Intraocular pressure (IOP) 30 mmHg by pneumatic tonometry; axial length 22.58 mm; woman patient:
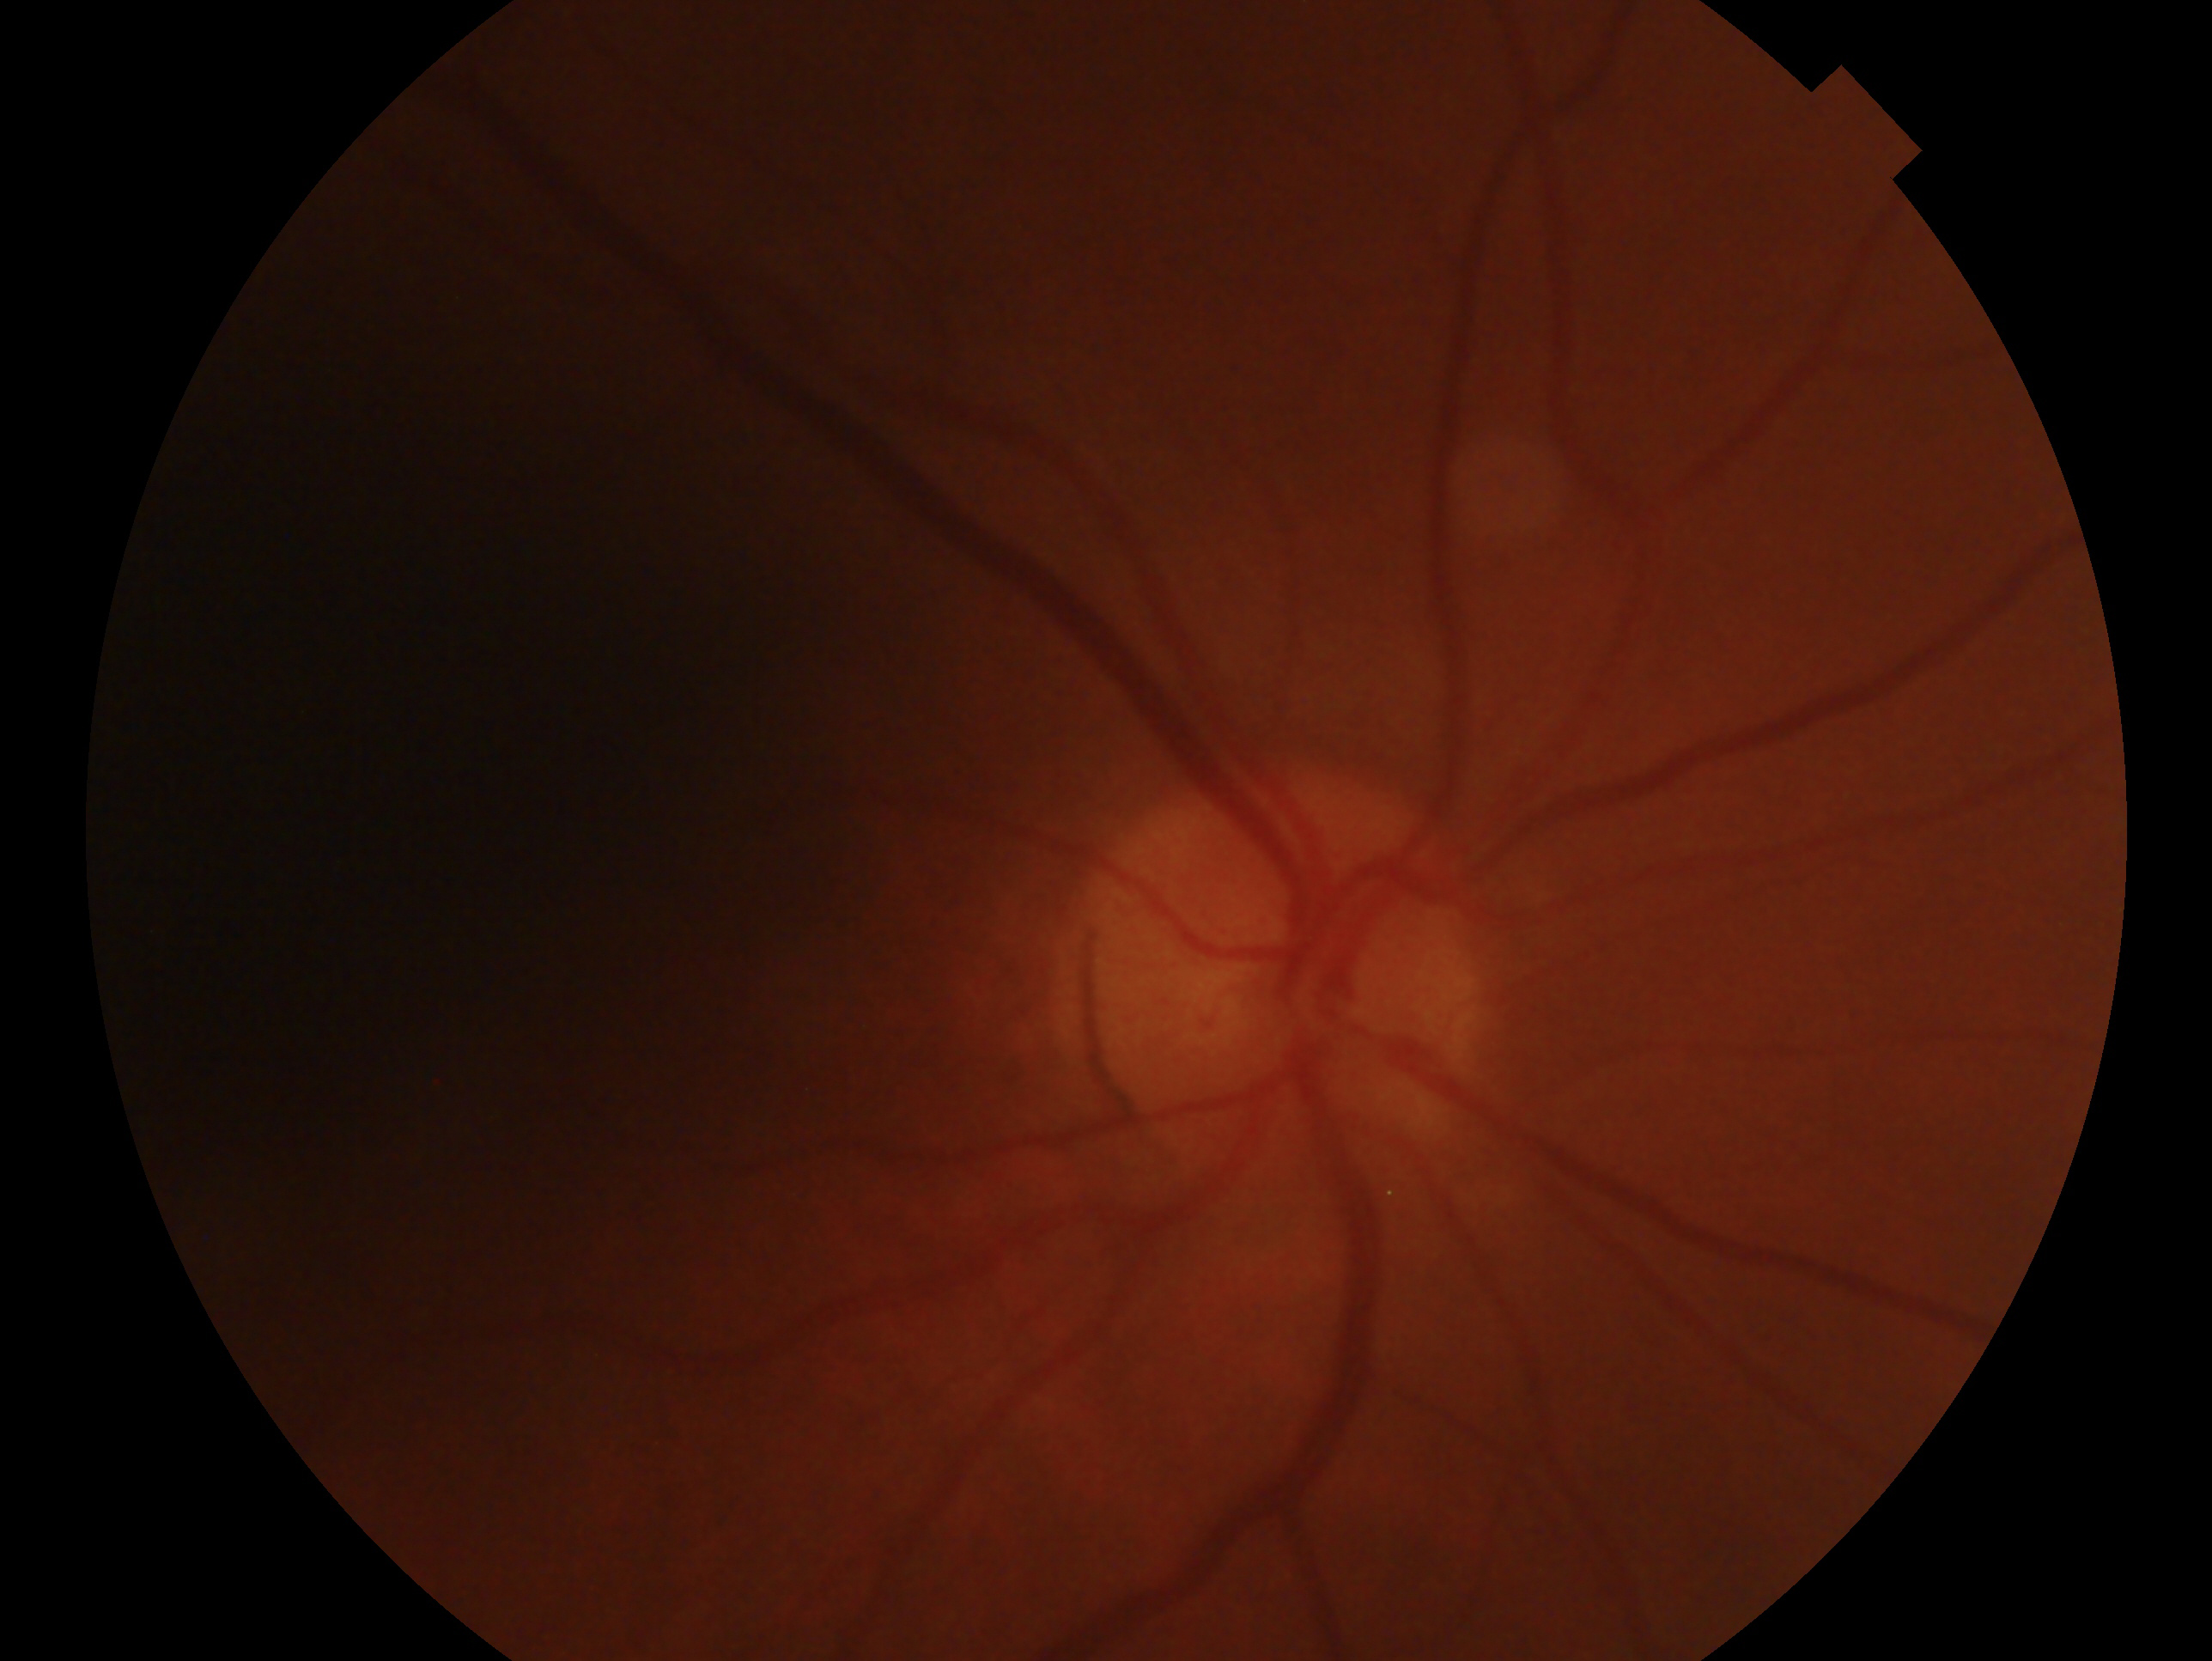 Eye: OD. Diagnosis — suspicious for glaucoma.